848 by 848 pixels · without pupil dilation.
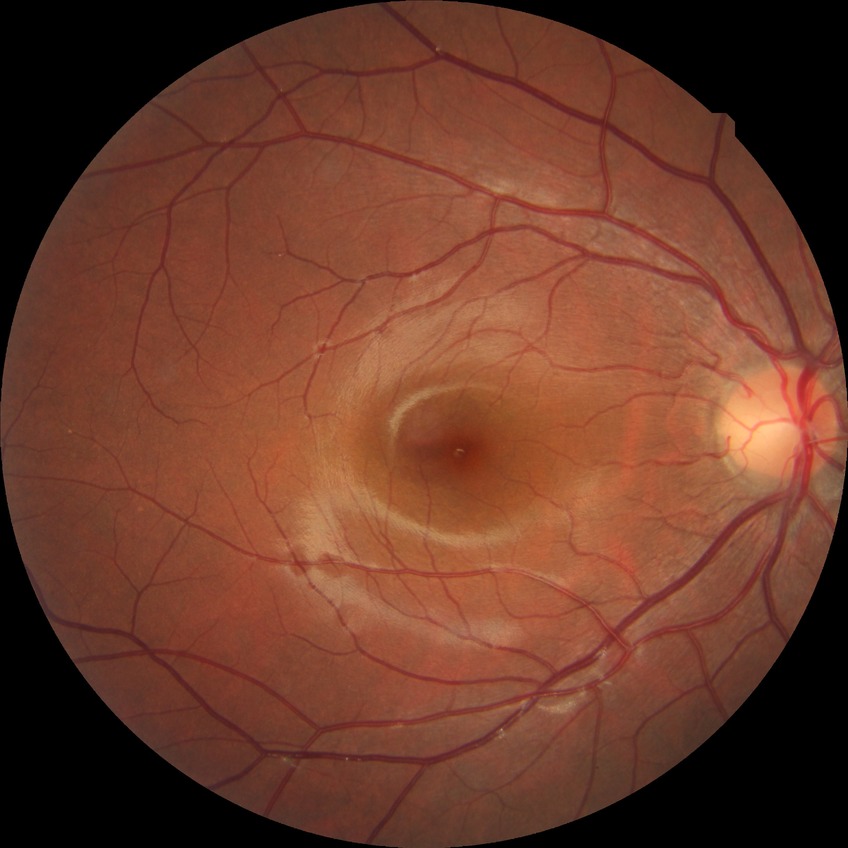
• modified Davis classification: no diabetic retinopathy